1659 by 2212 pixels
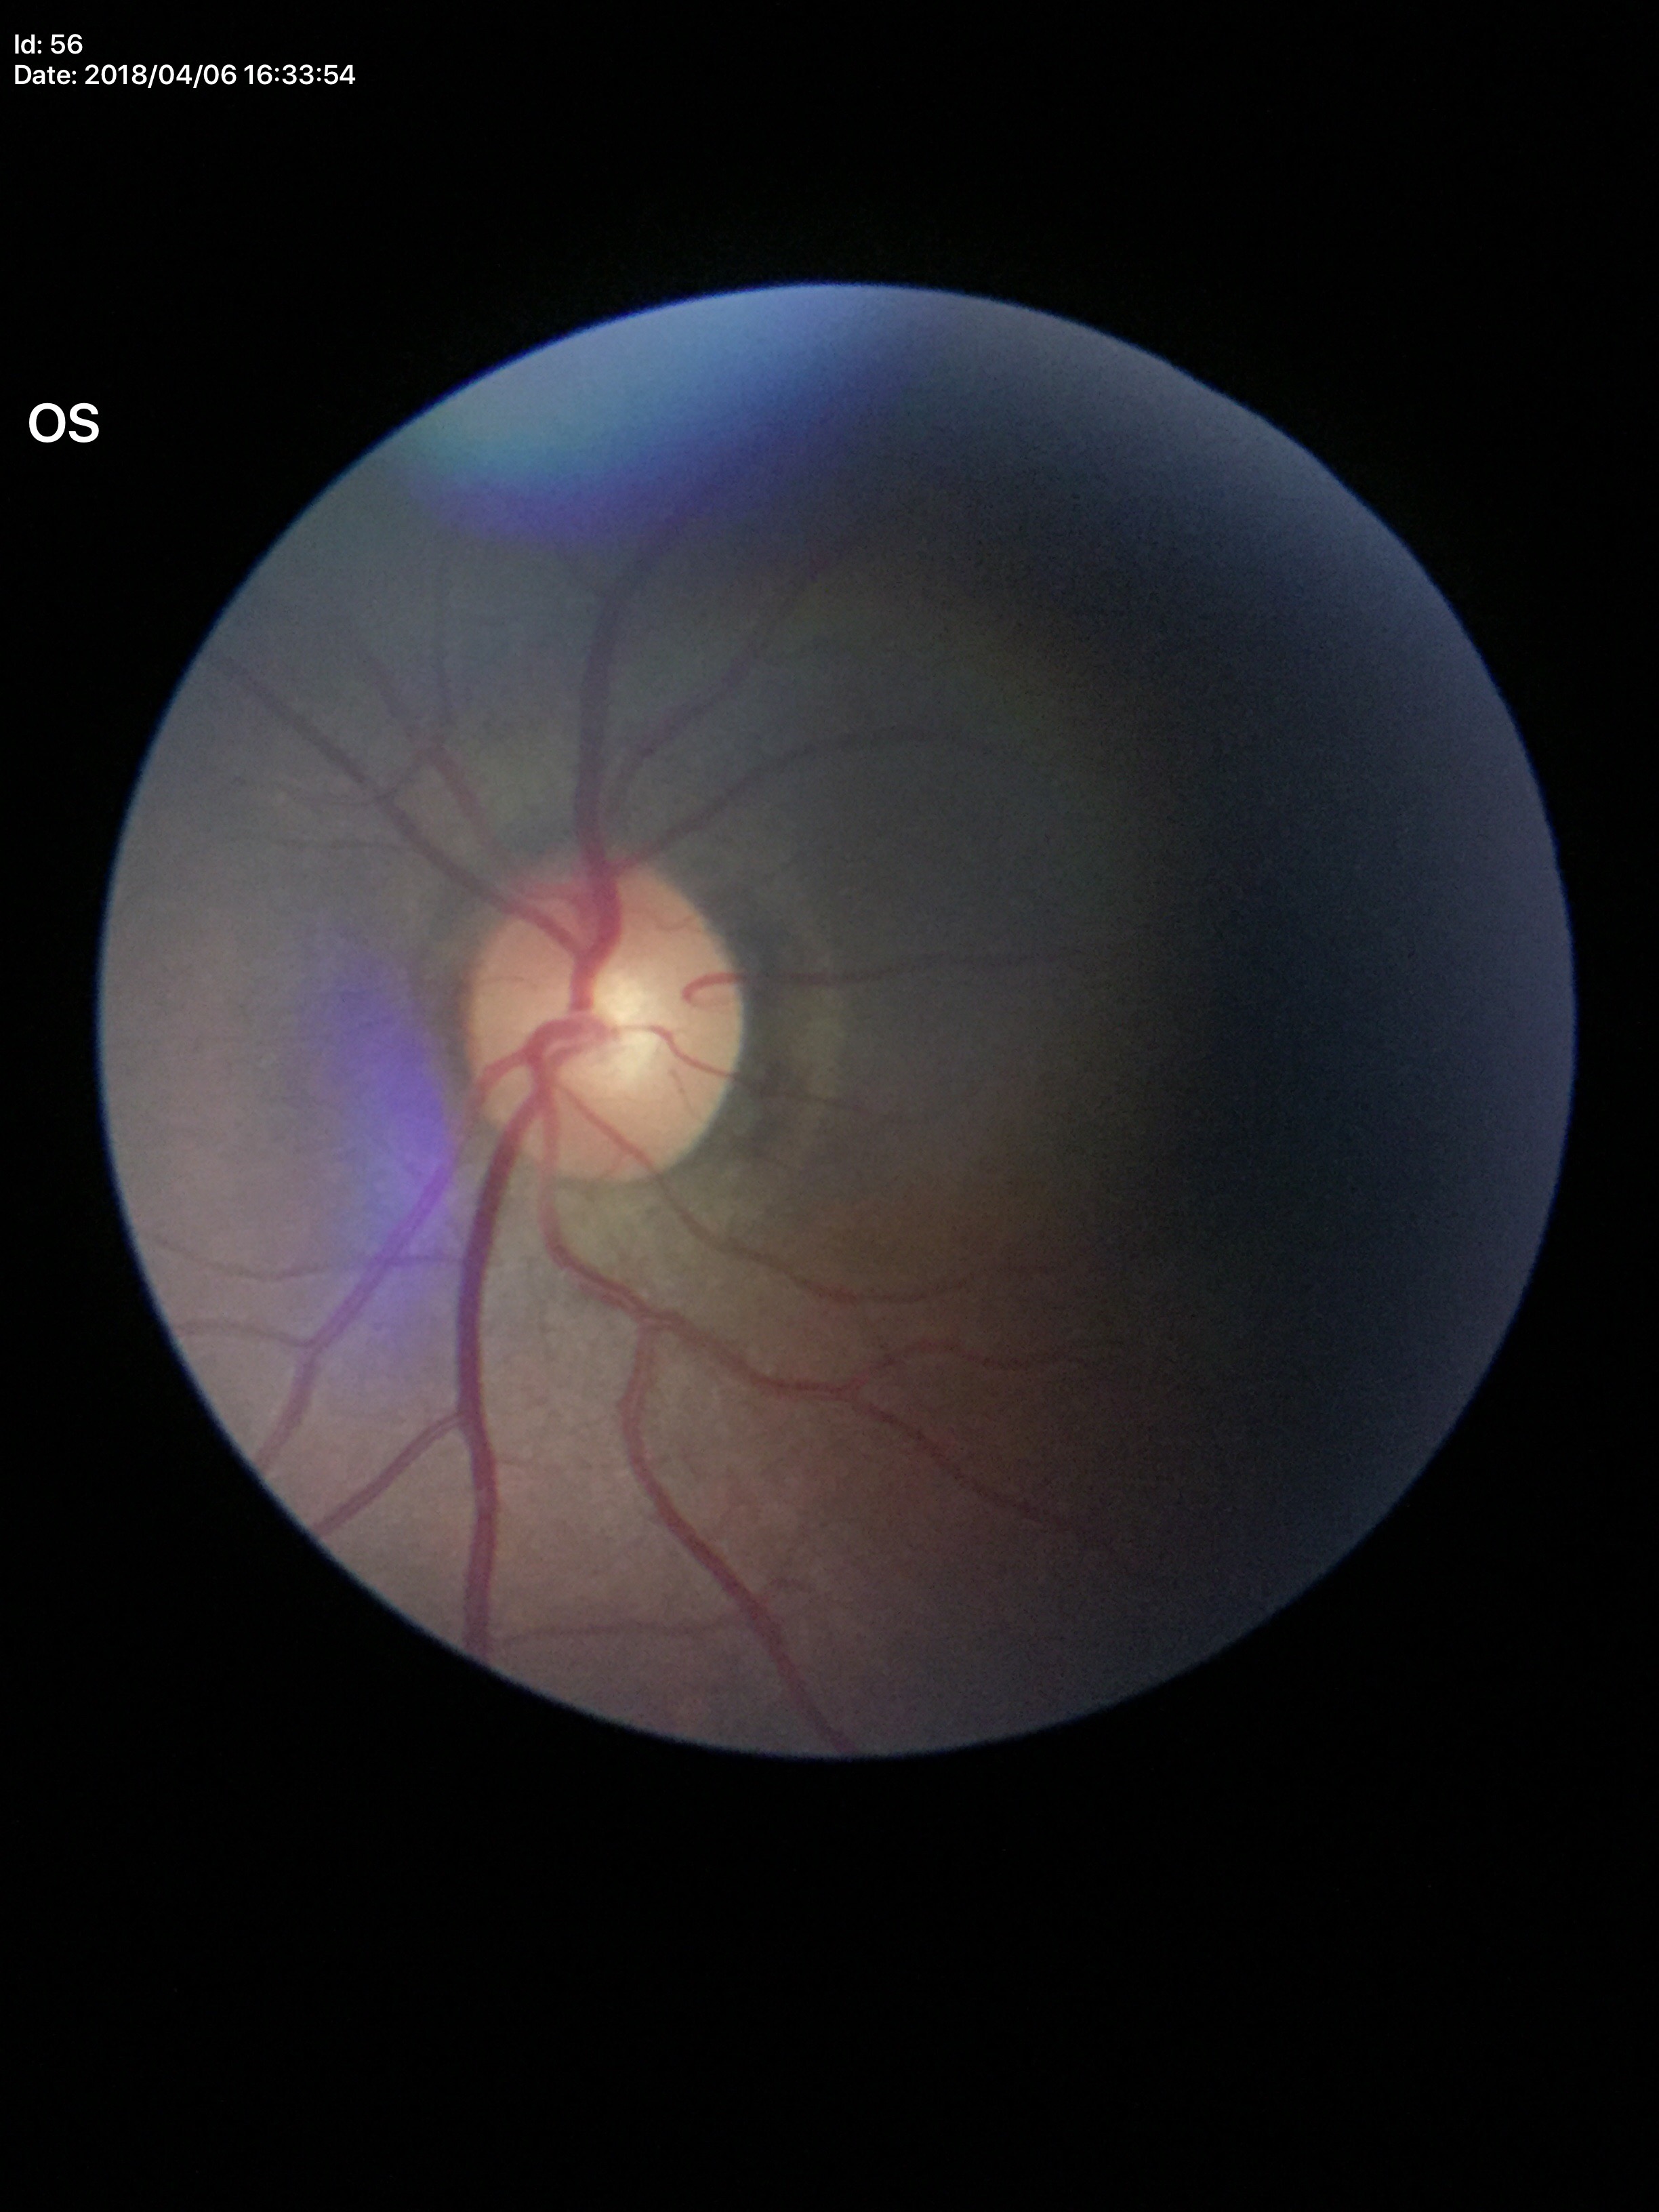 Glaucoma evaluation = no suspicious findings
VCDR = 0.50
HCDR = 0.53